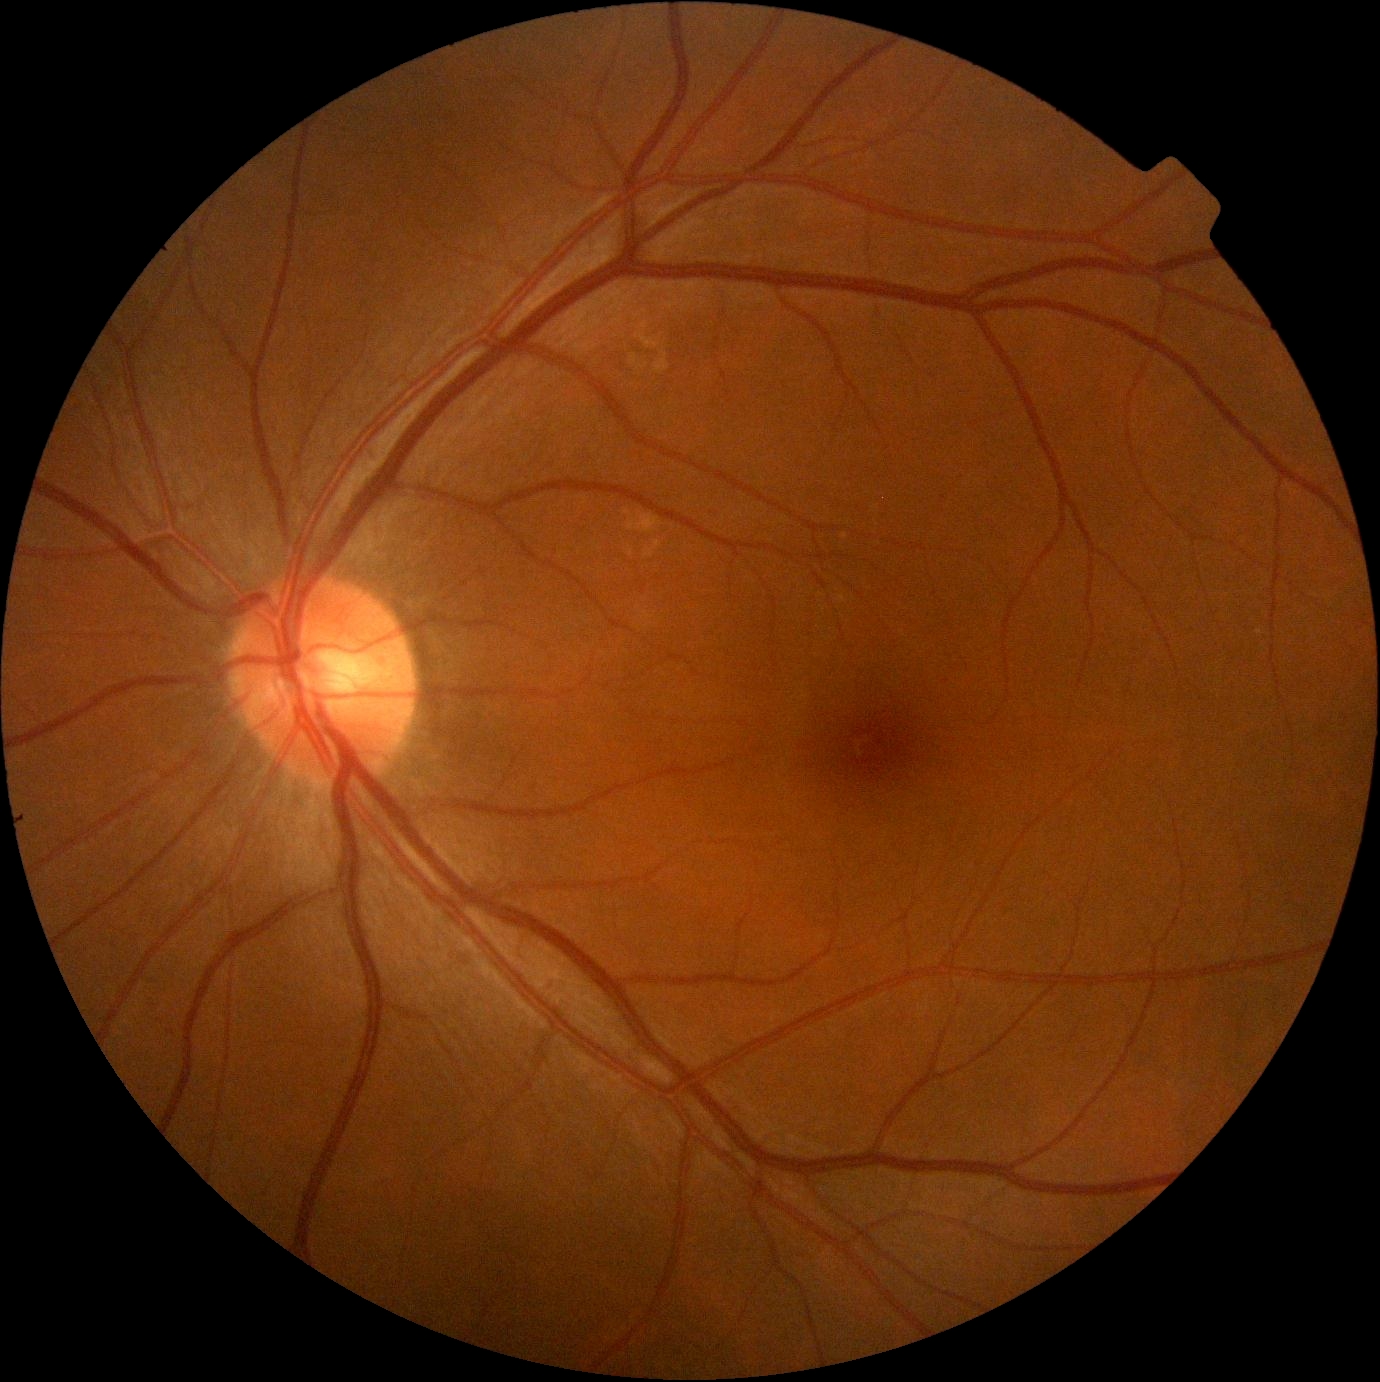

No diabetic retinal disease findings.
DR: 0/4 — no visible signs of diabetic retinopathy.